1534 by 1534 pixels, CFP: 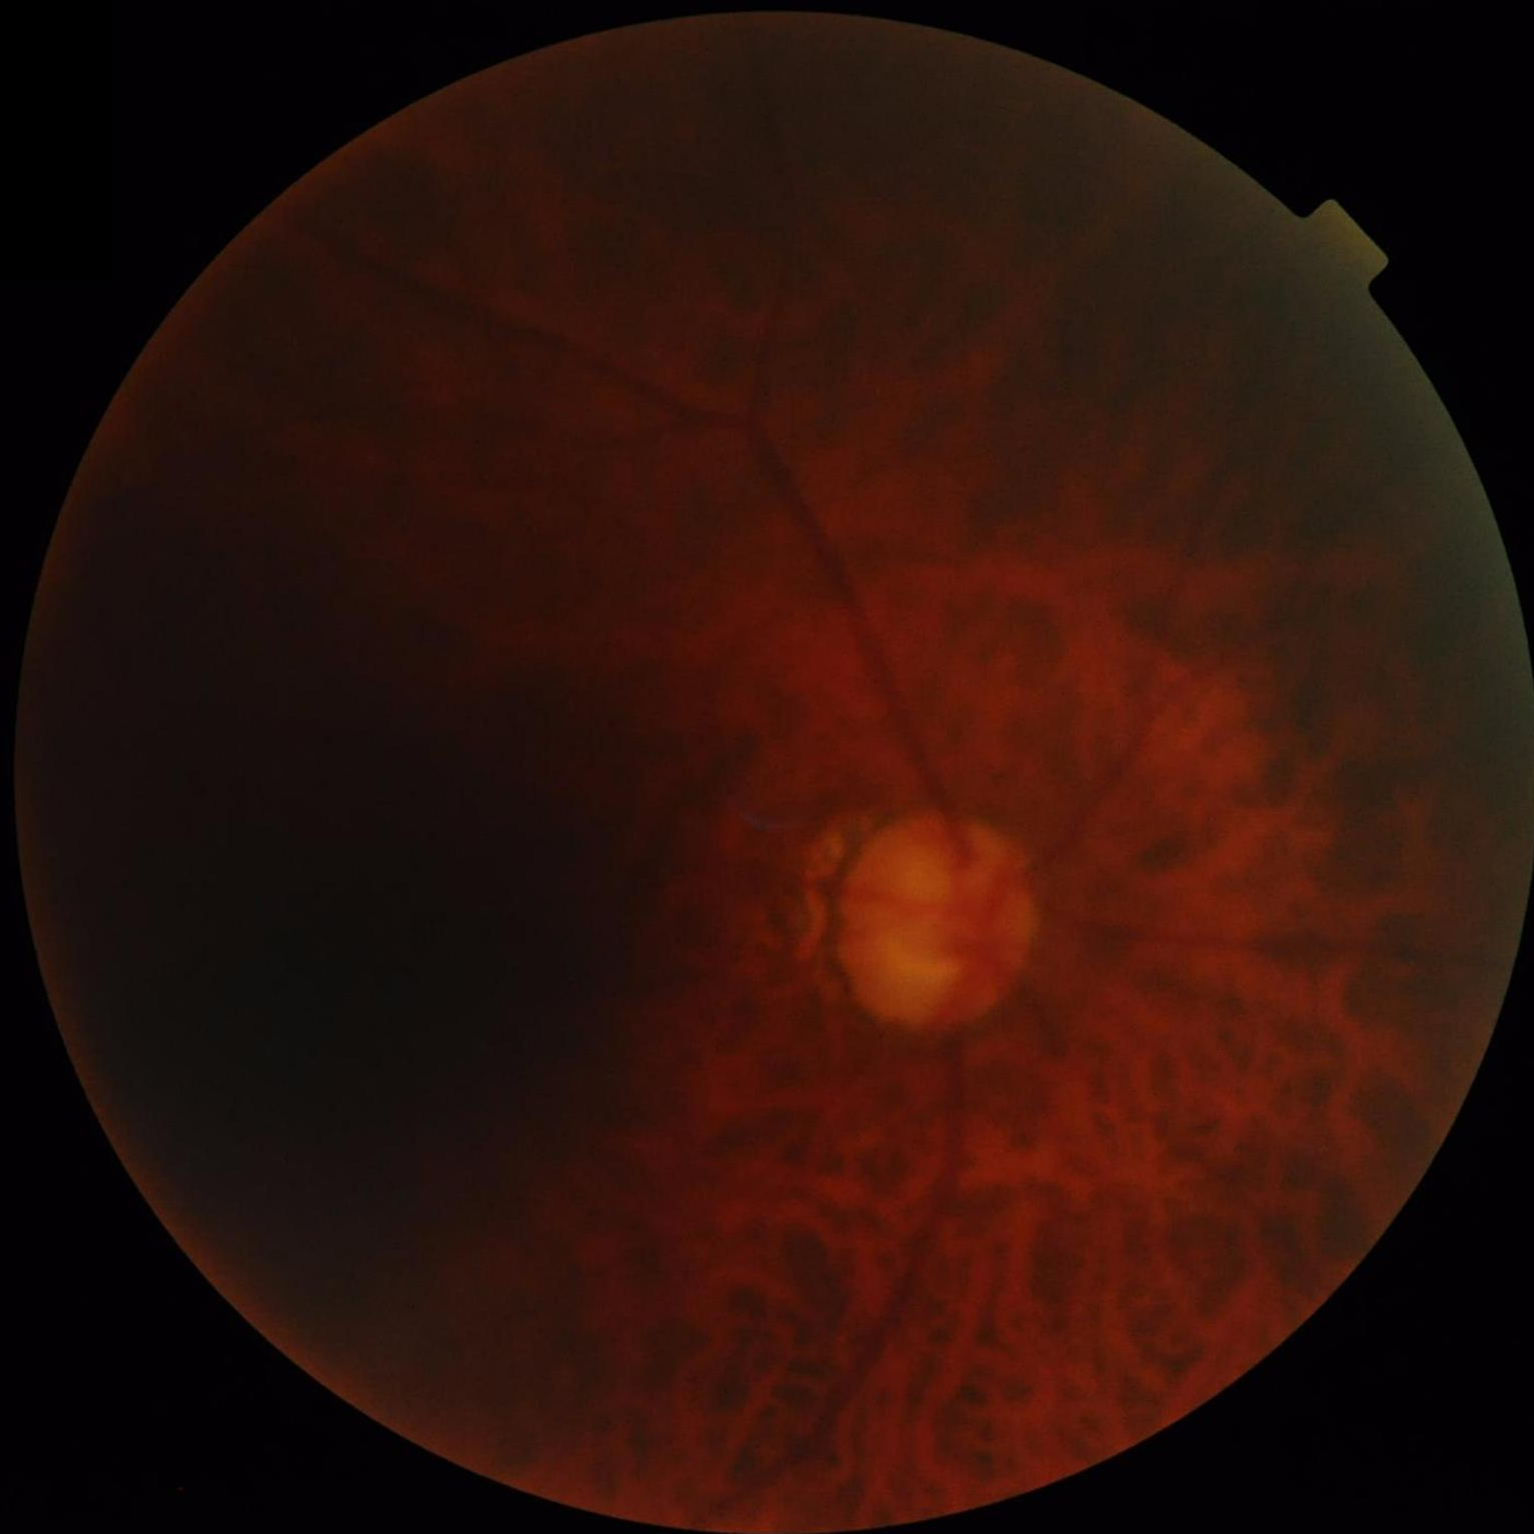

Reduced sharpness with visible blur.
Overall image quality is poor.
Contrast is low.
There is over- or under-exposure or a color cast.